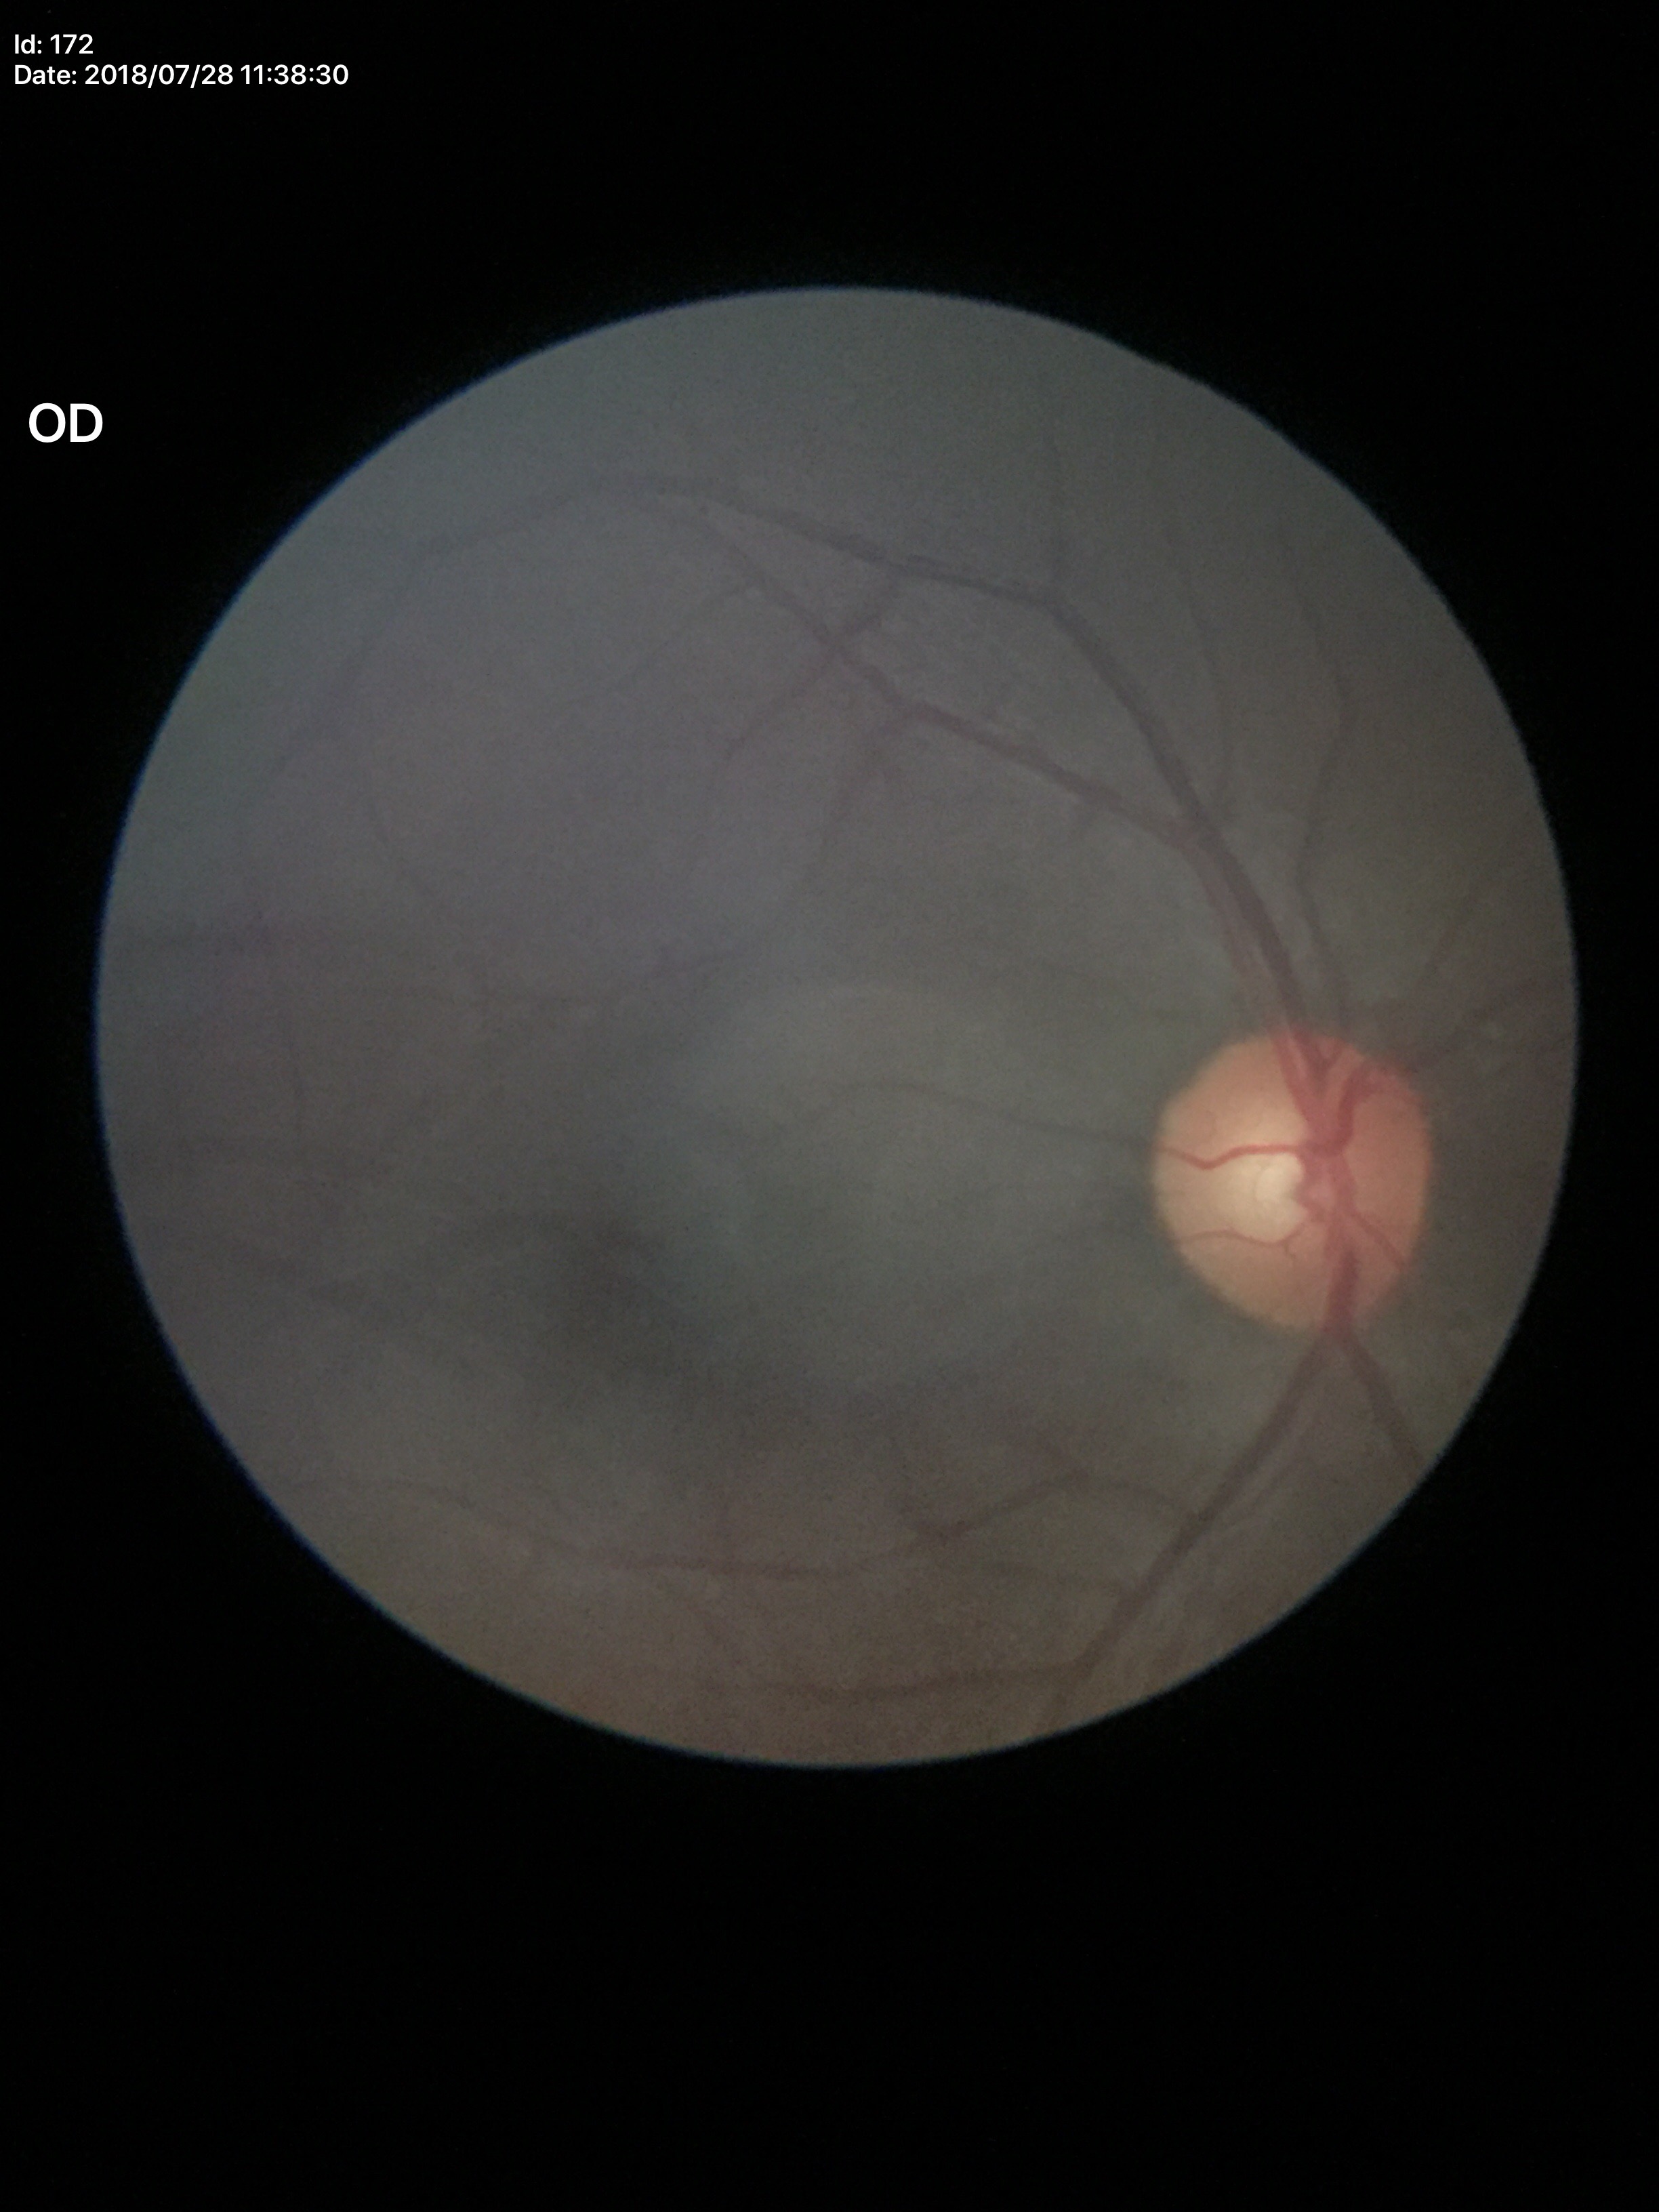
Glaucoma evaluation: no suspicious findings.
Vertical cup-to-disc ratio (VCDR) is 0.53.